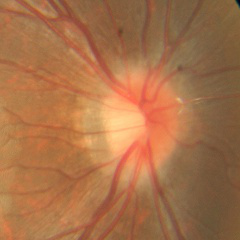 Q: What stage of glaucoma is present?
A: No — no signs of glaucoma.